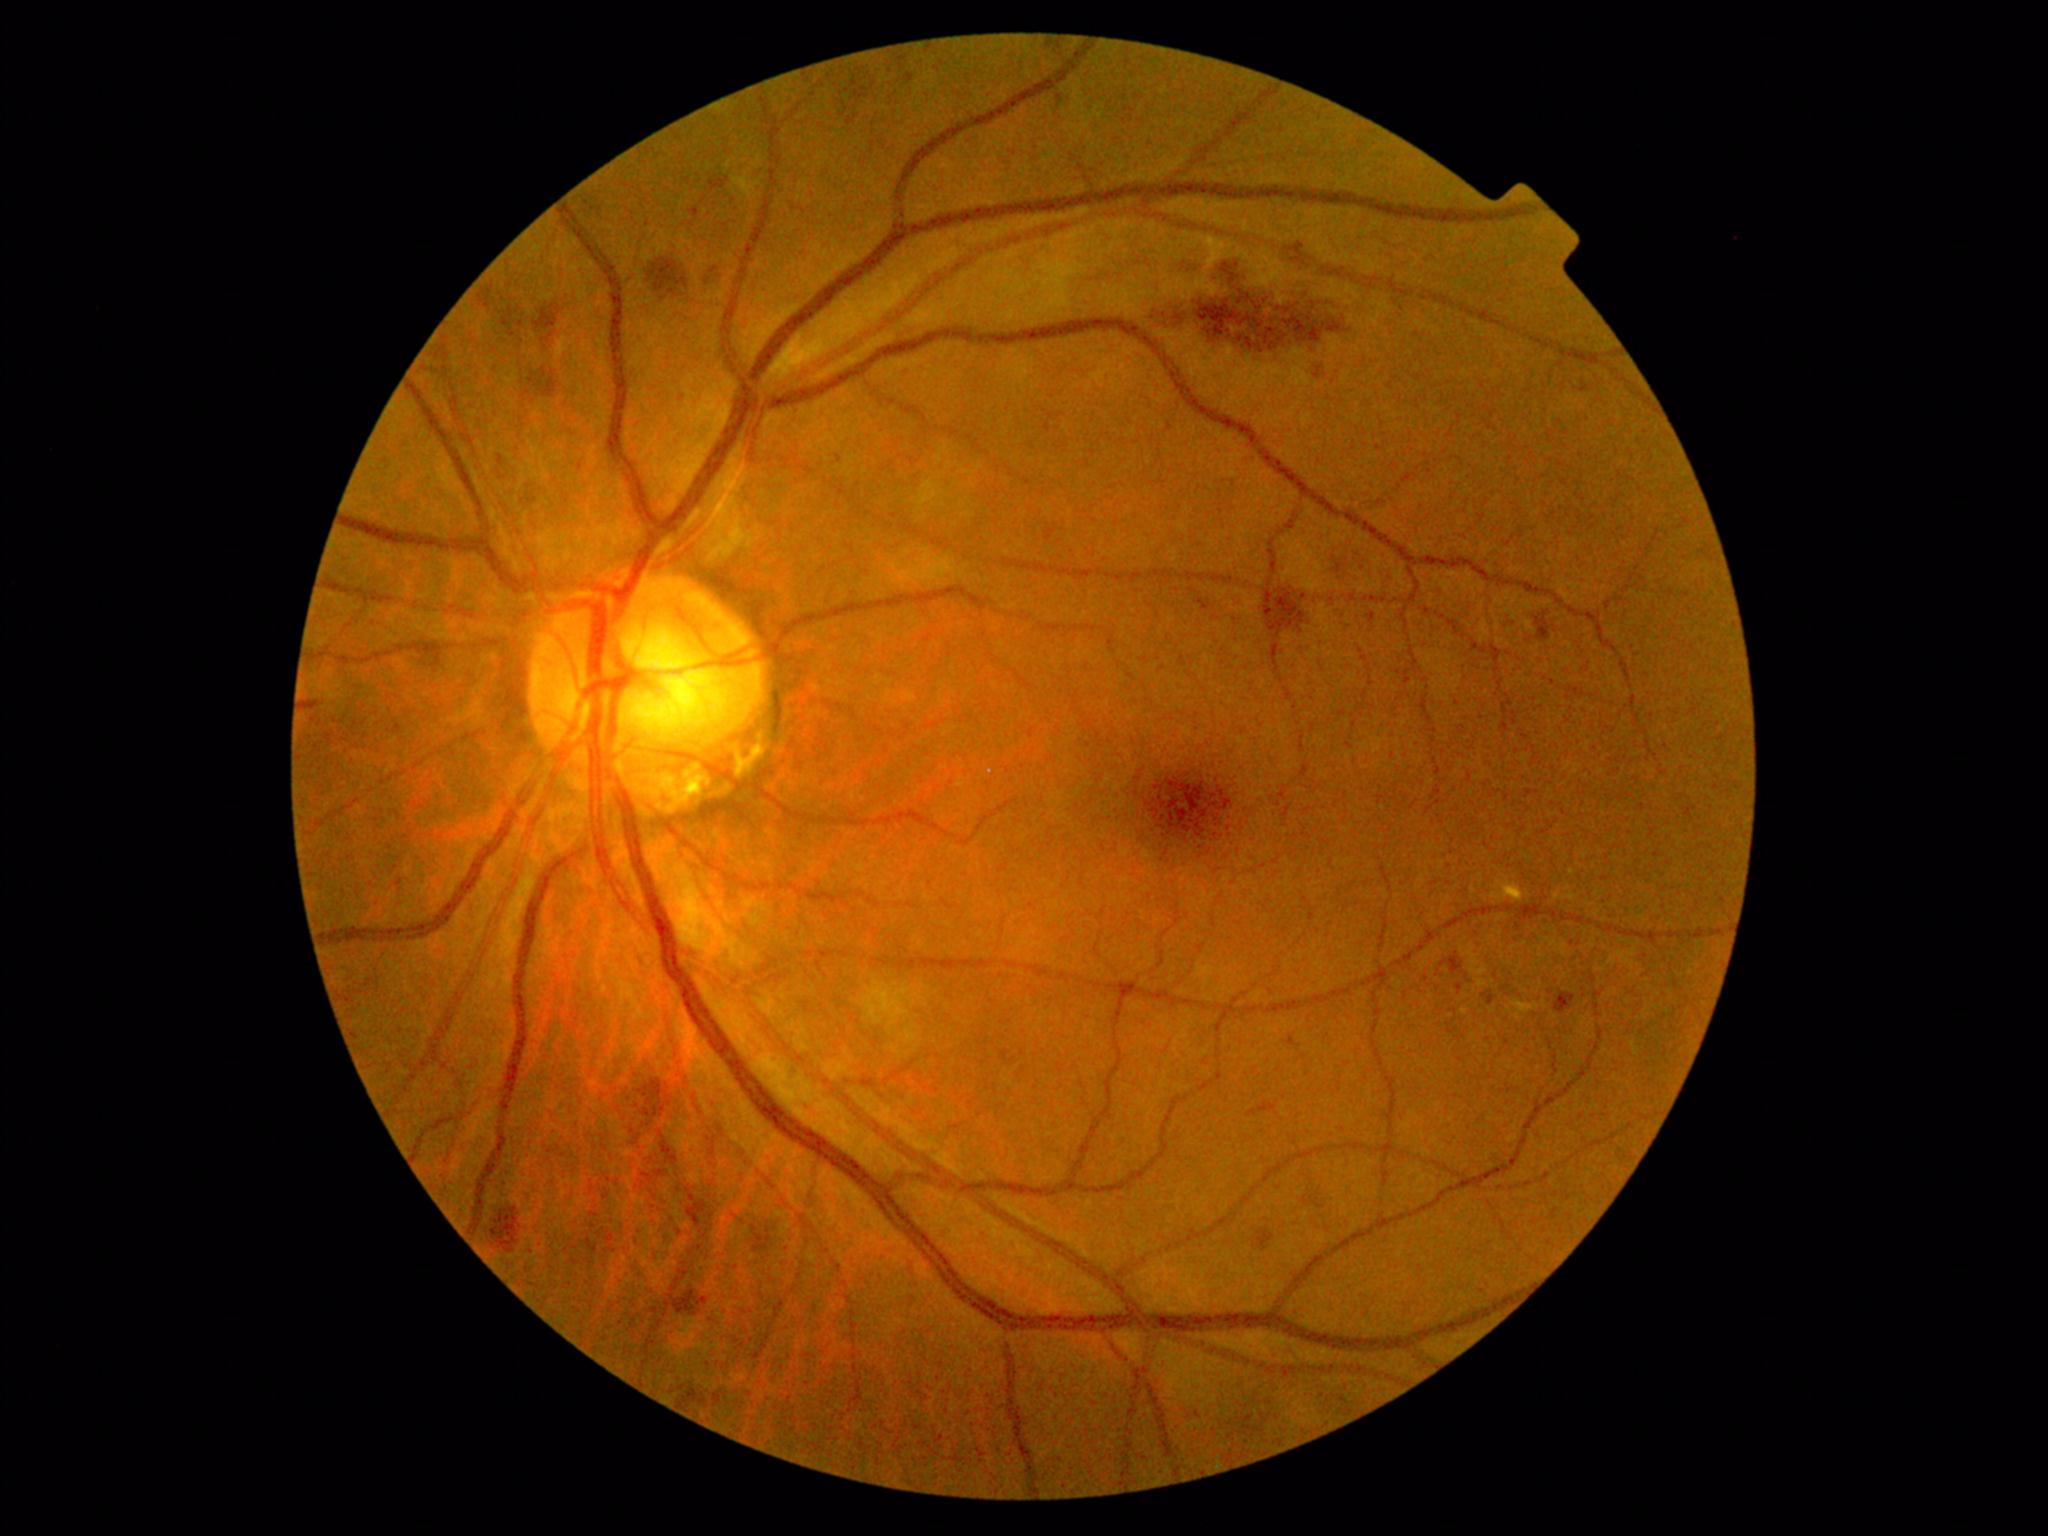

Diabetic retinopathy (DR): grade 2; non-proliferative diabetic retinopathy
Lesions identified (partial list):
• hemorrhages (HEs) (more not shown): x1=1453 y1=956 x2=1466 y2=985 | x1=489 y1=289 x2=525 y2=334 | x1=1179 y1=265 x2=1208 y2=279 | x1=1268 y1=587 x2=1307 y2=633 | x1=420 y1=641 x2=444 y2=669 | x1=684 y1=1191 x2=699 y2=1203 | x1=1536 y1=617 x2=1550 y2=640 | x1=1043 y1=43 x2=1060 y2=50 | x1=499 y1=457 x2=516 y2=478 | x1=532 y1=372 x2=553 y2=401 | x1=711 y1=179 x2=729 y2=191 | x1=671 y1=1291 x2=709 y2=1312 | x1=655 y1=1133 x2=676 y2=1161 | x1=303 y1=702 x2=320 y2=710 | x1=636 y1=1080 x2=669 y2=1118 | x1=688 y1=1201 x2=706 y2=1227